Color fundus photograph · acquired with a NIDEK AFC-230 · 848x848px · graded on the modified Davis scale:
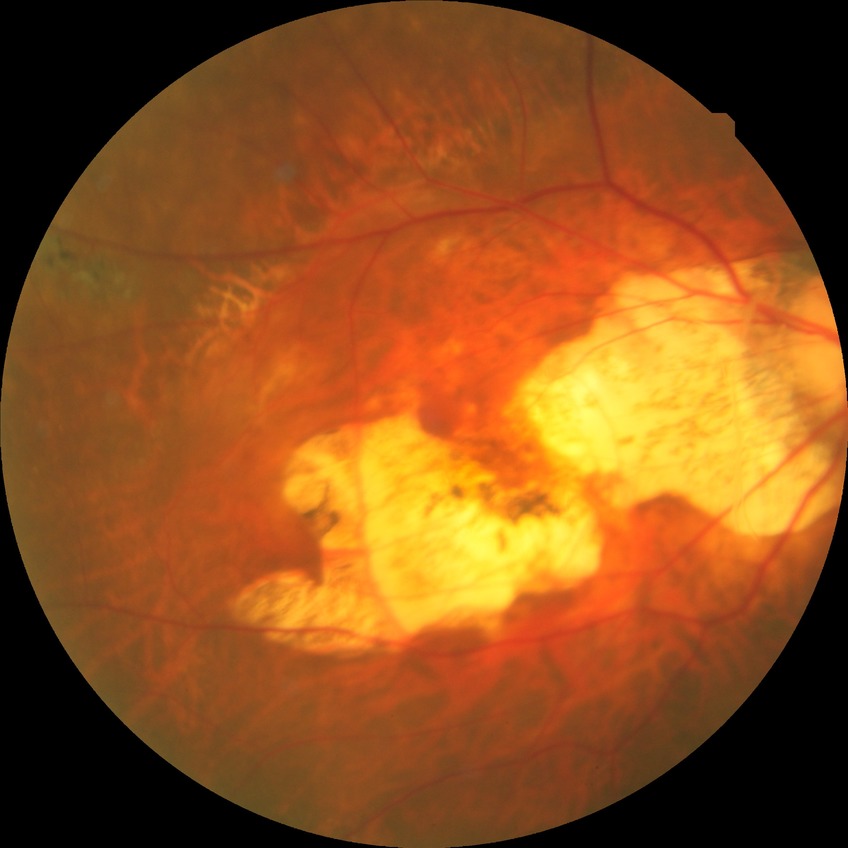
Retinopathy grade is no diabetic retinopathy.